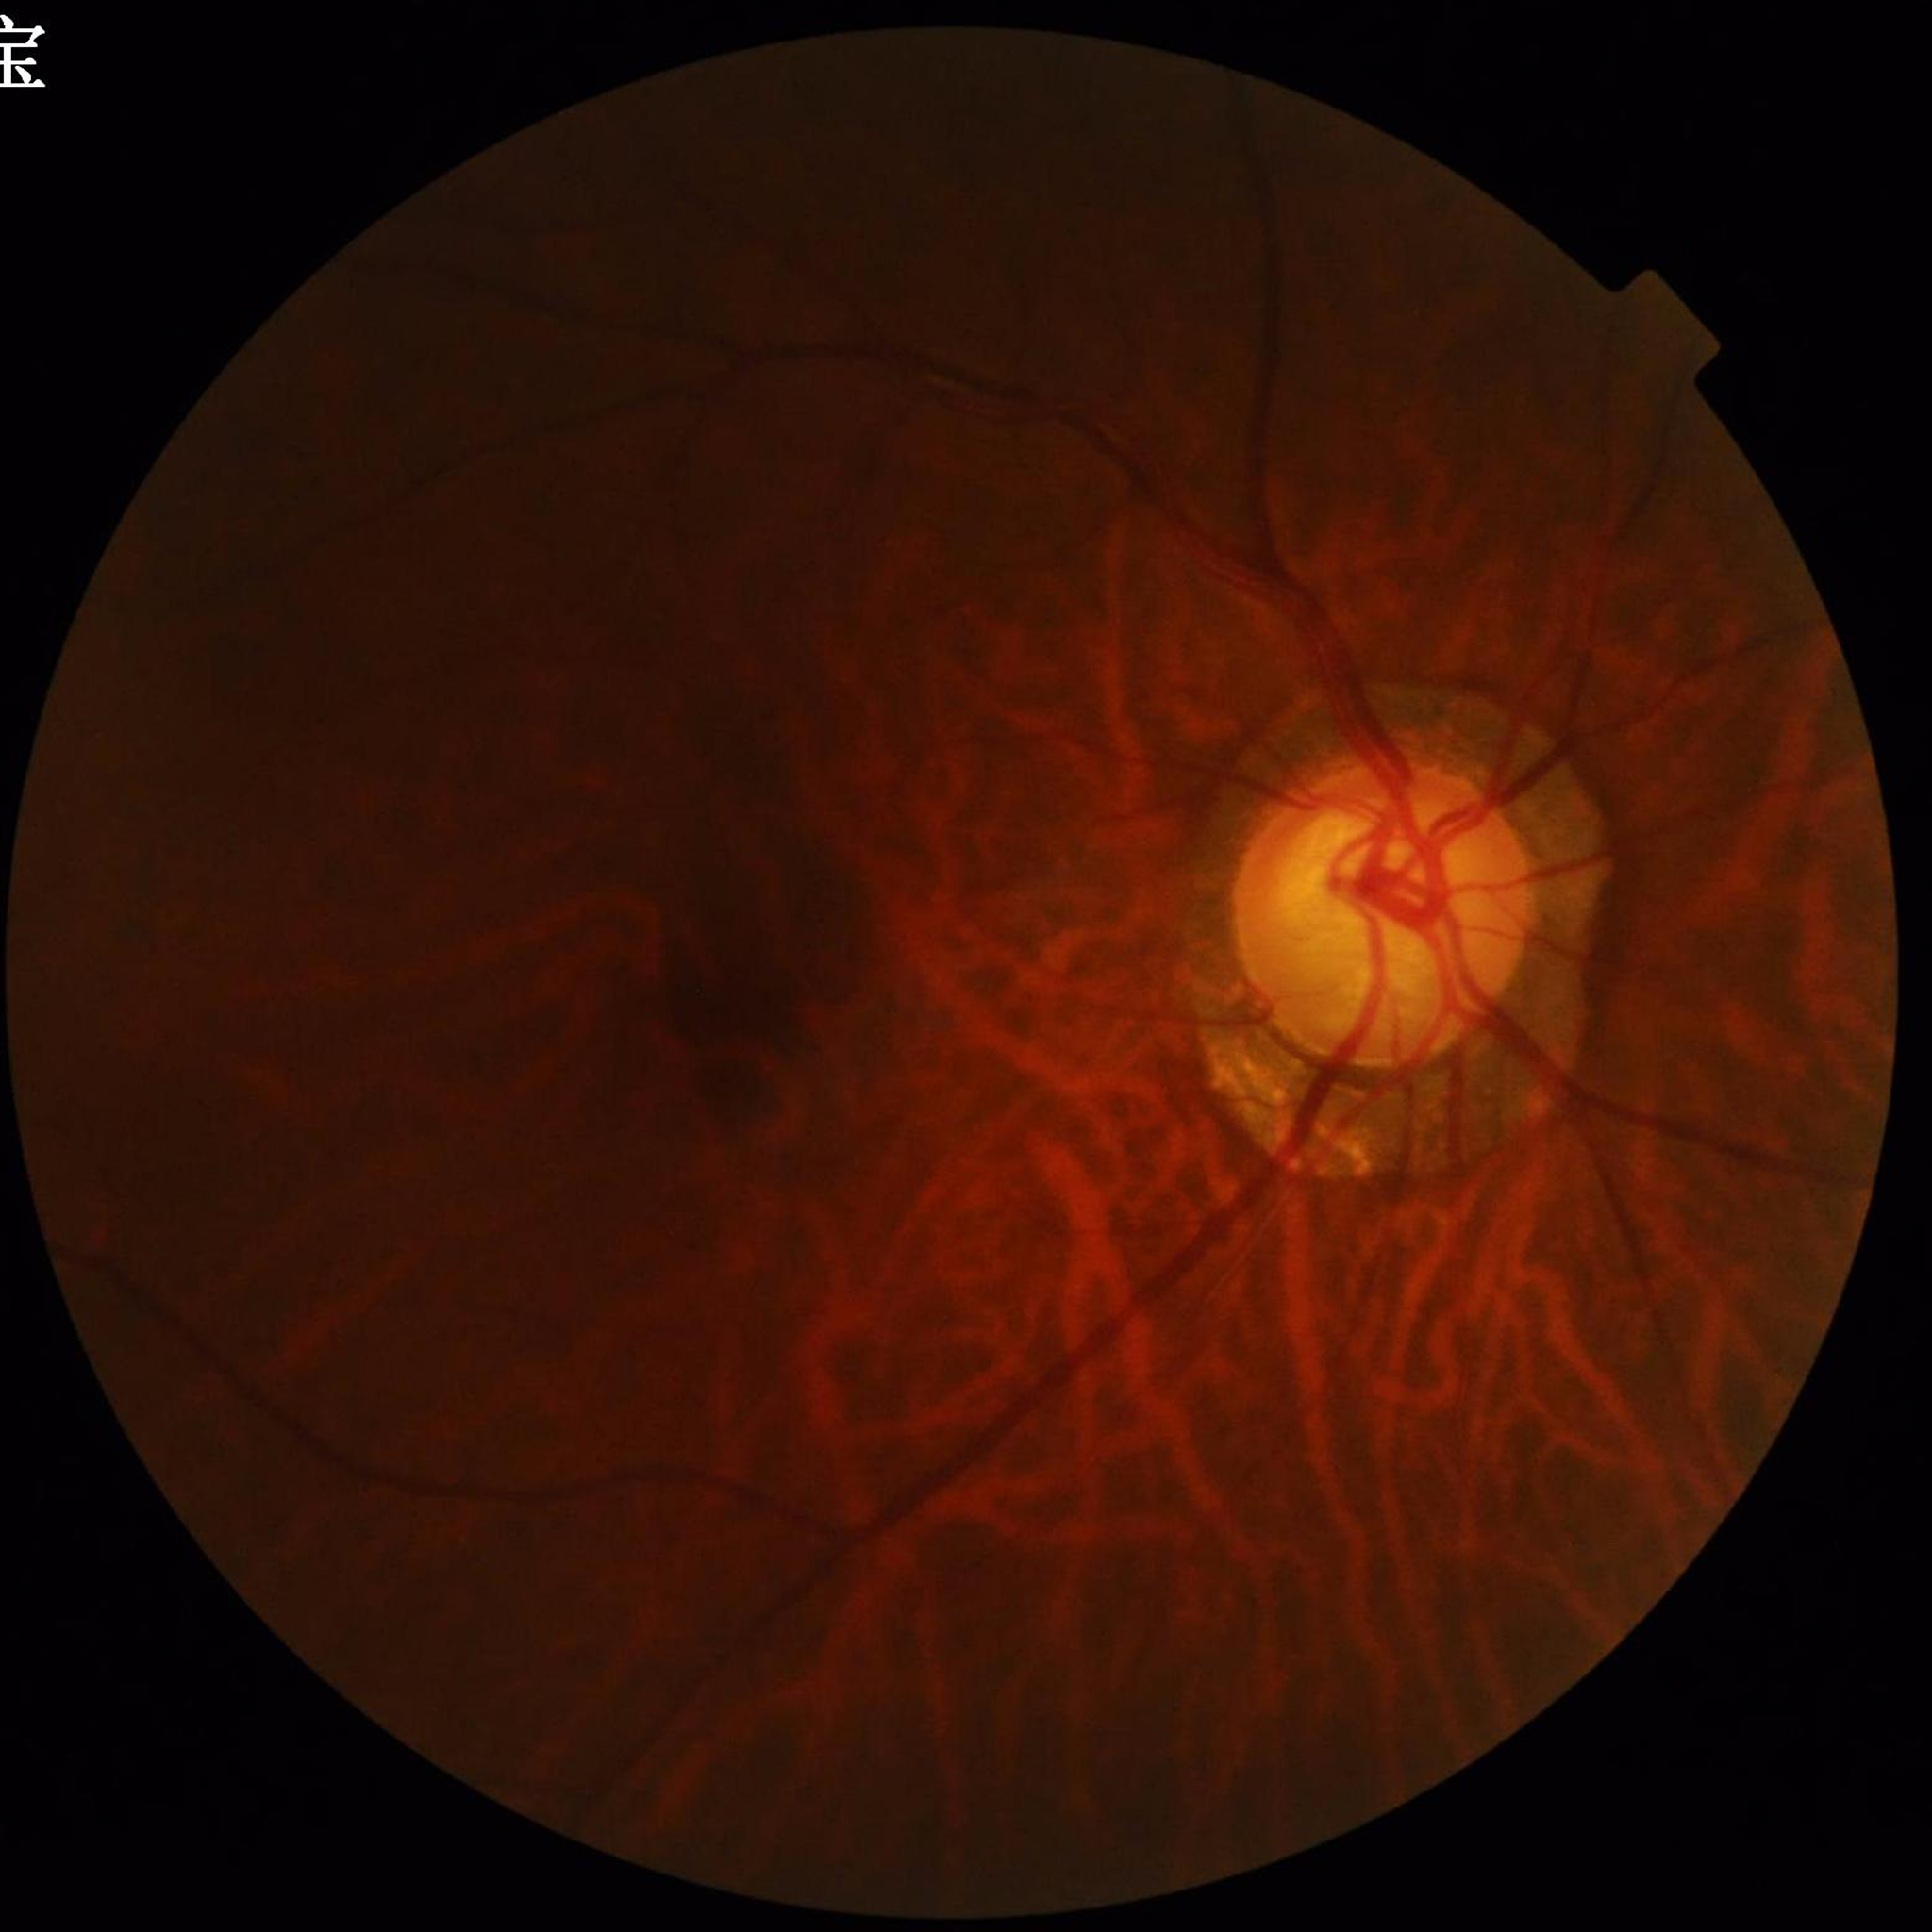

Condition: glaucoma; Photo quality: poor — illumination/color distortion.